2352 by 1568 pixels:
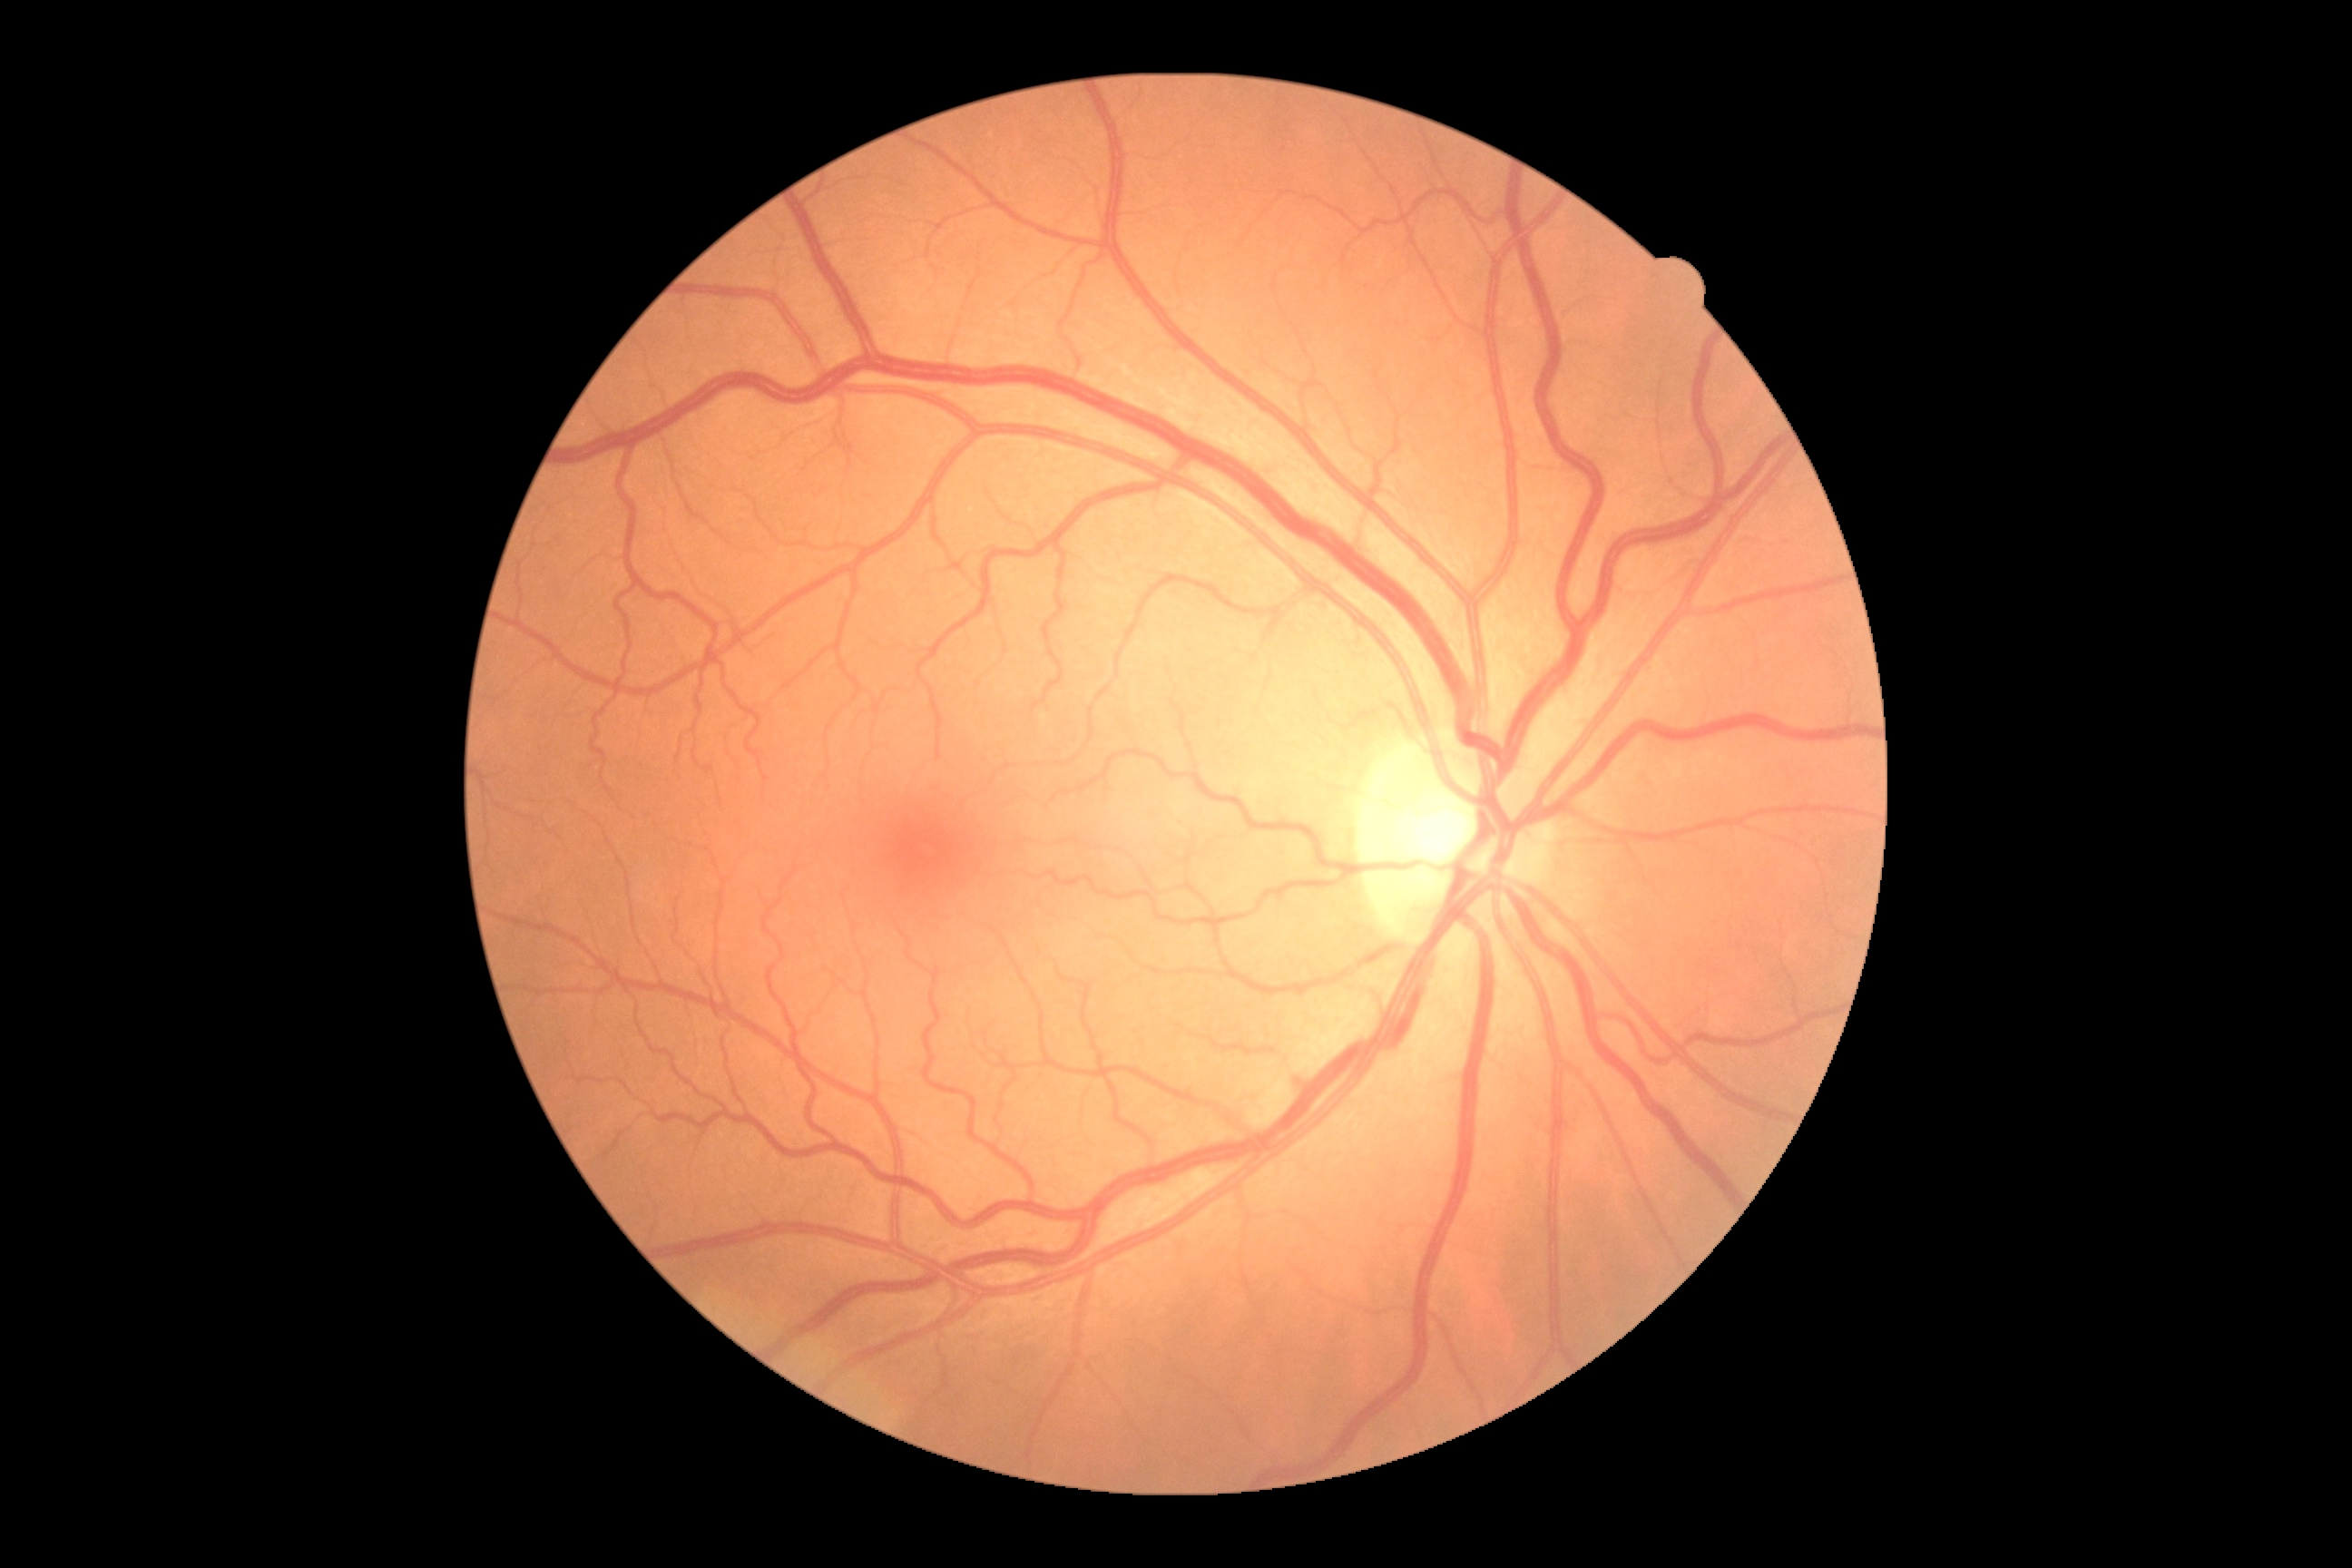
DR grade: 0 (no apparent retinopathy).